Color fundus photograph. 45° FOV
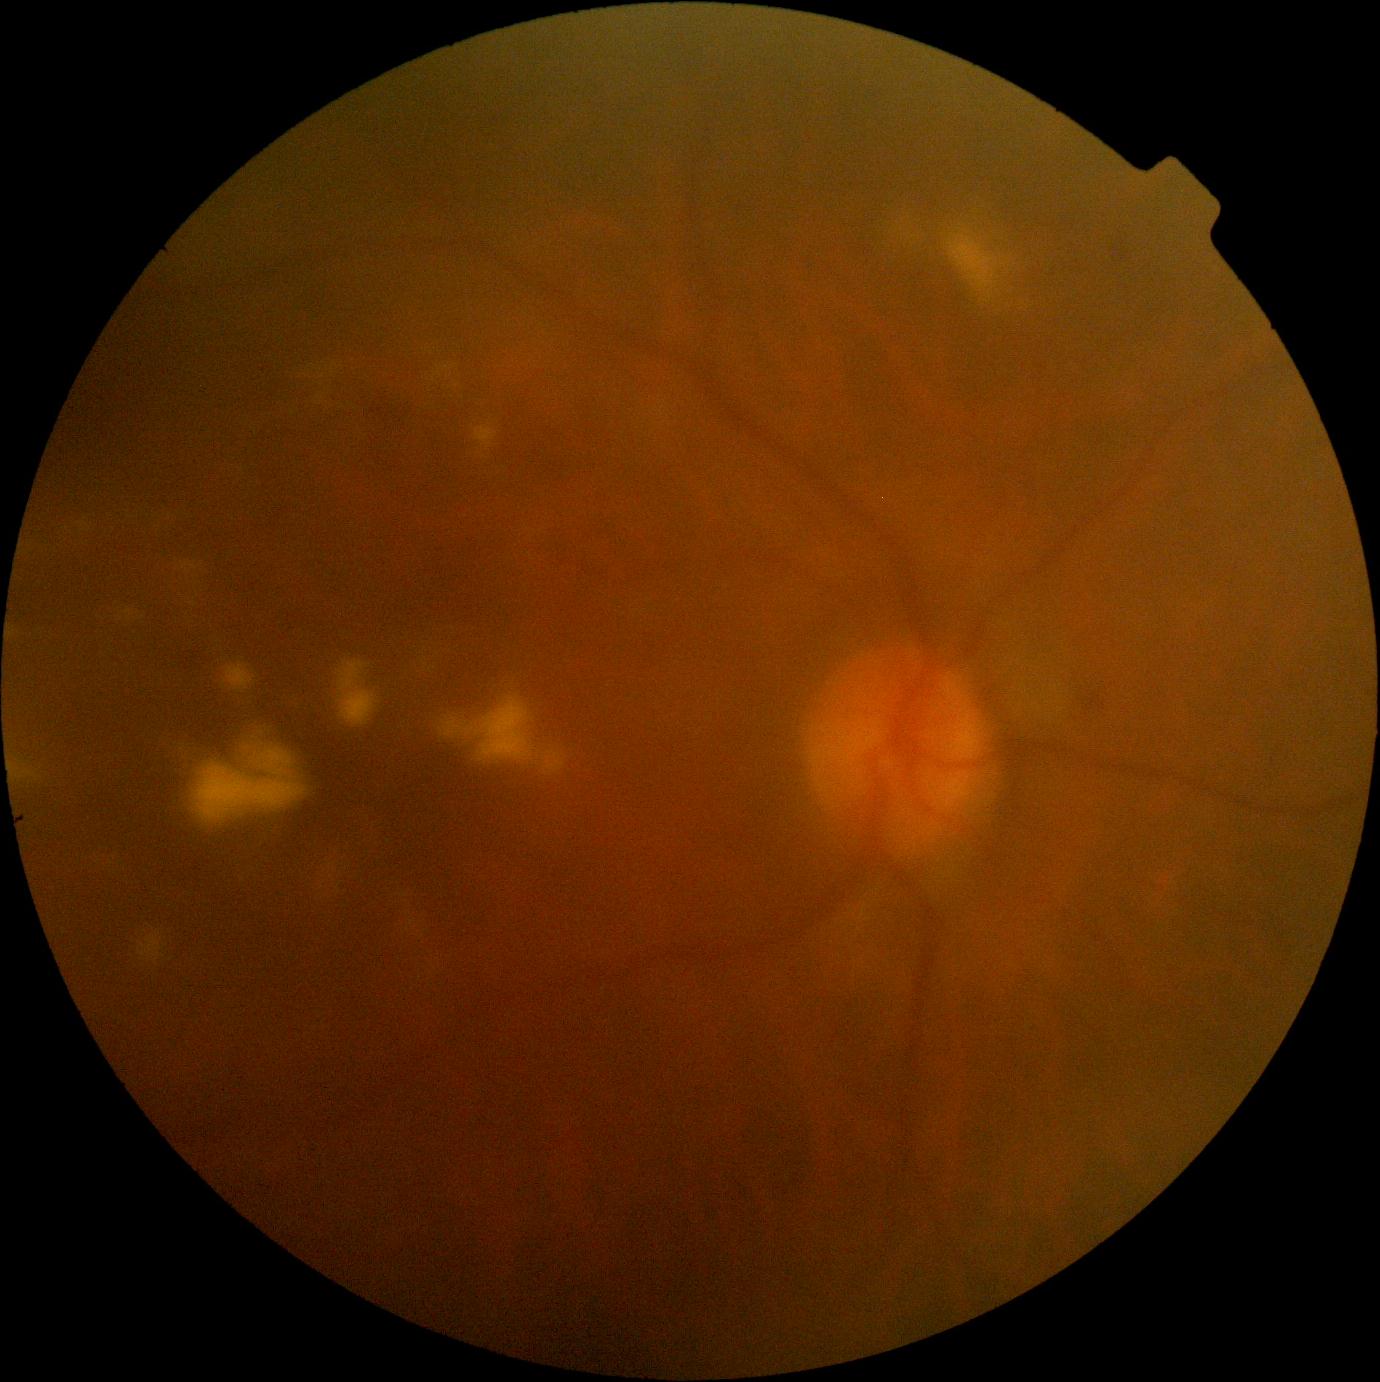

Annotations:
- diabetic retinopathy (DR) — moderate non-proliferative diabetic retinopathy (grade 2) — more than just microaneurysms but less than severe NPDR